Retinal fundus photograph.
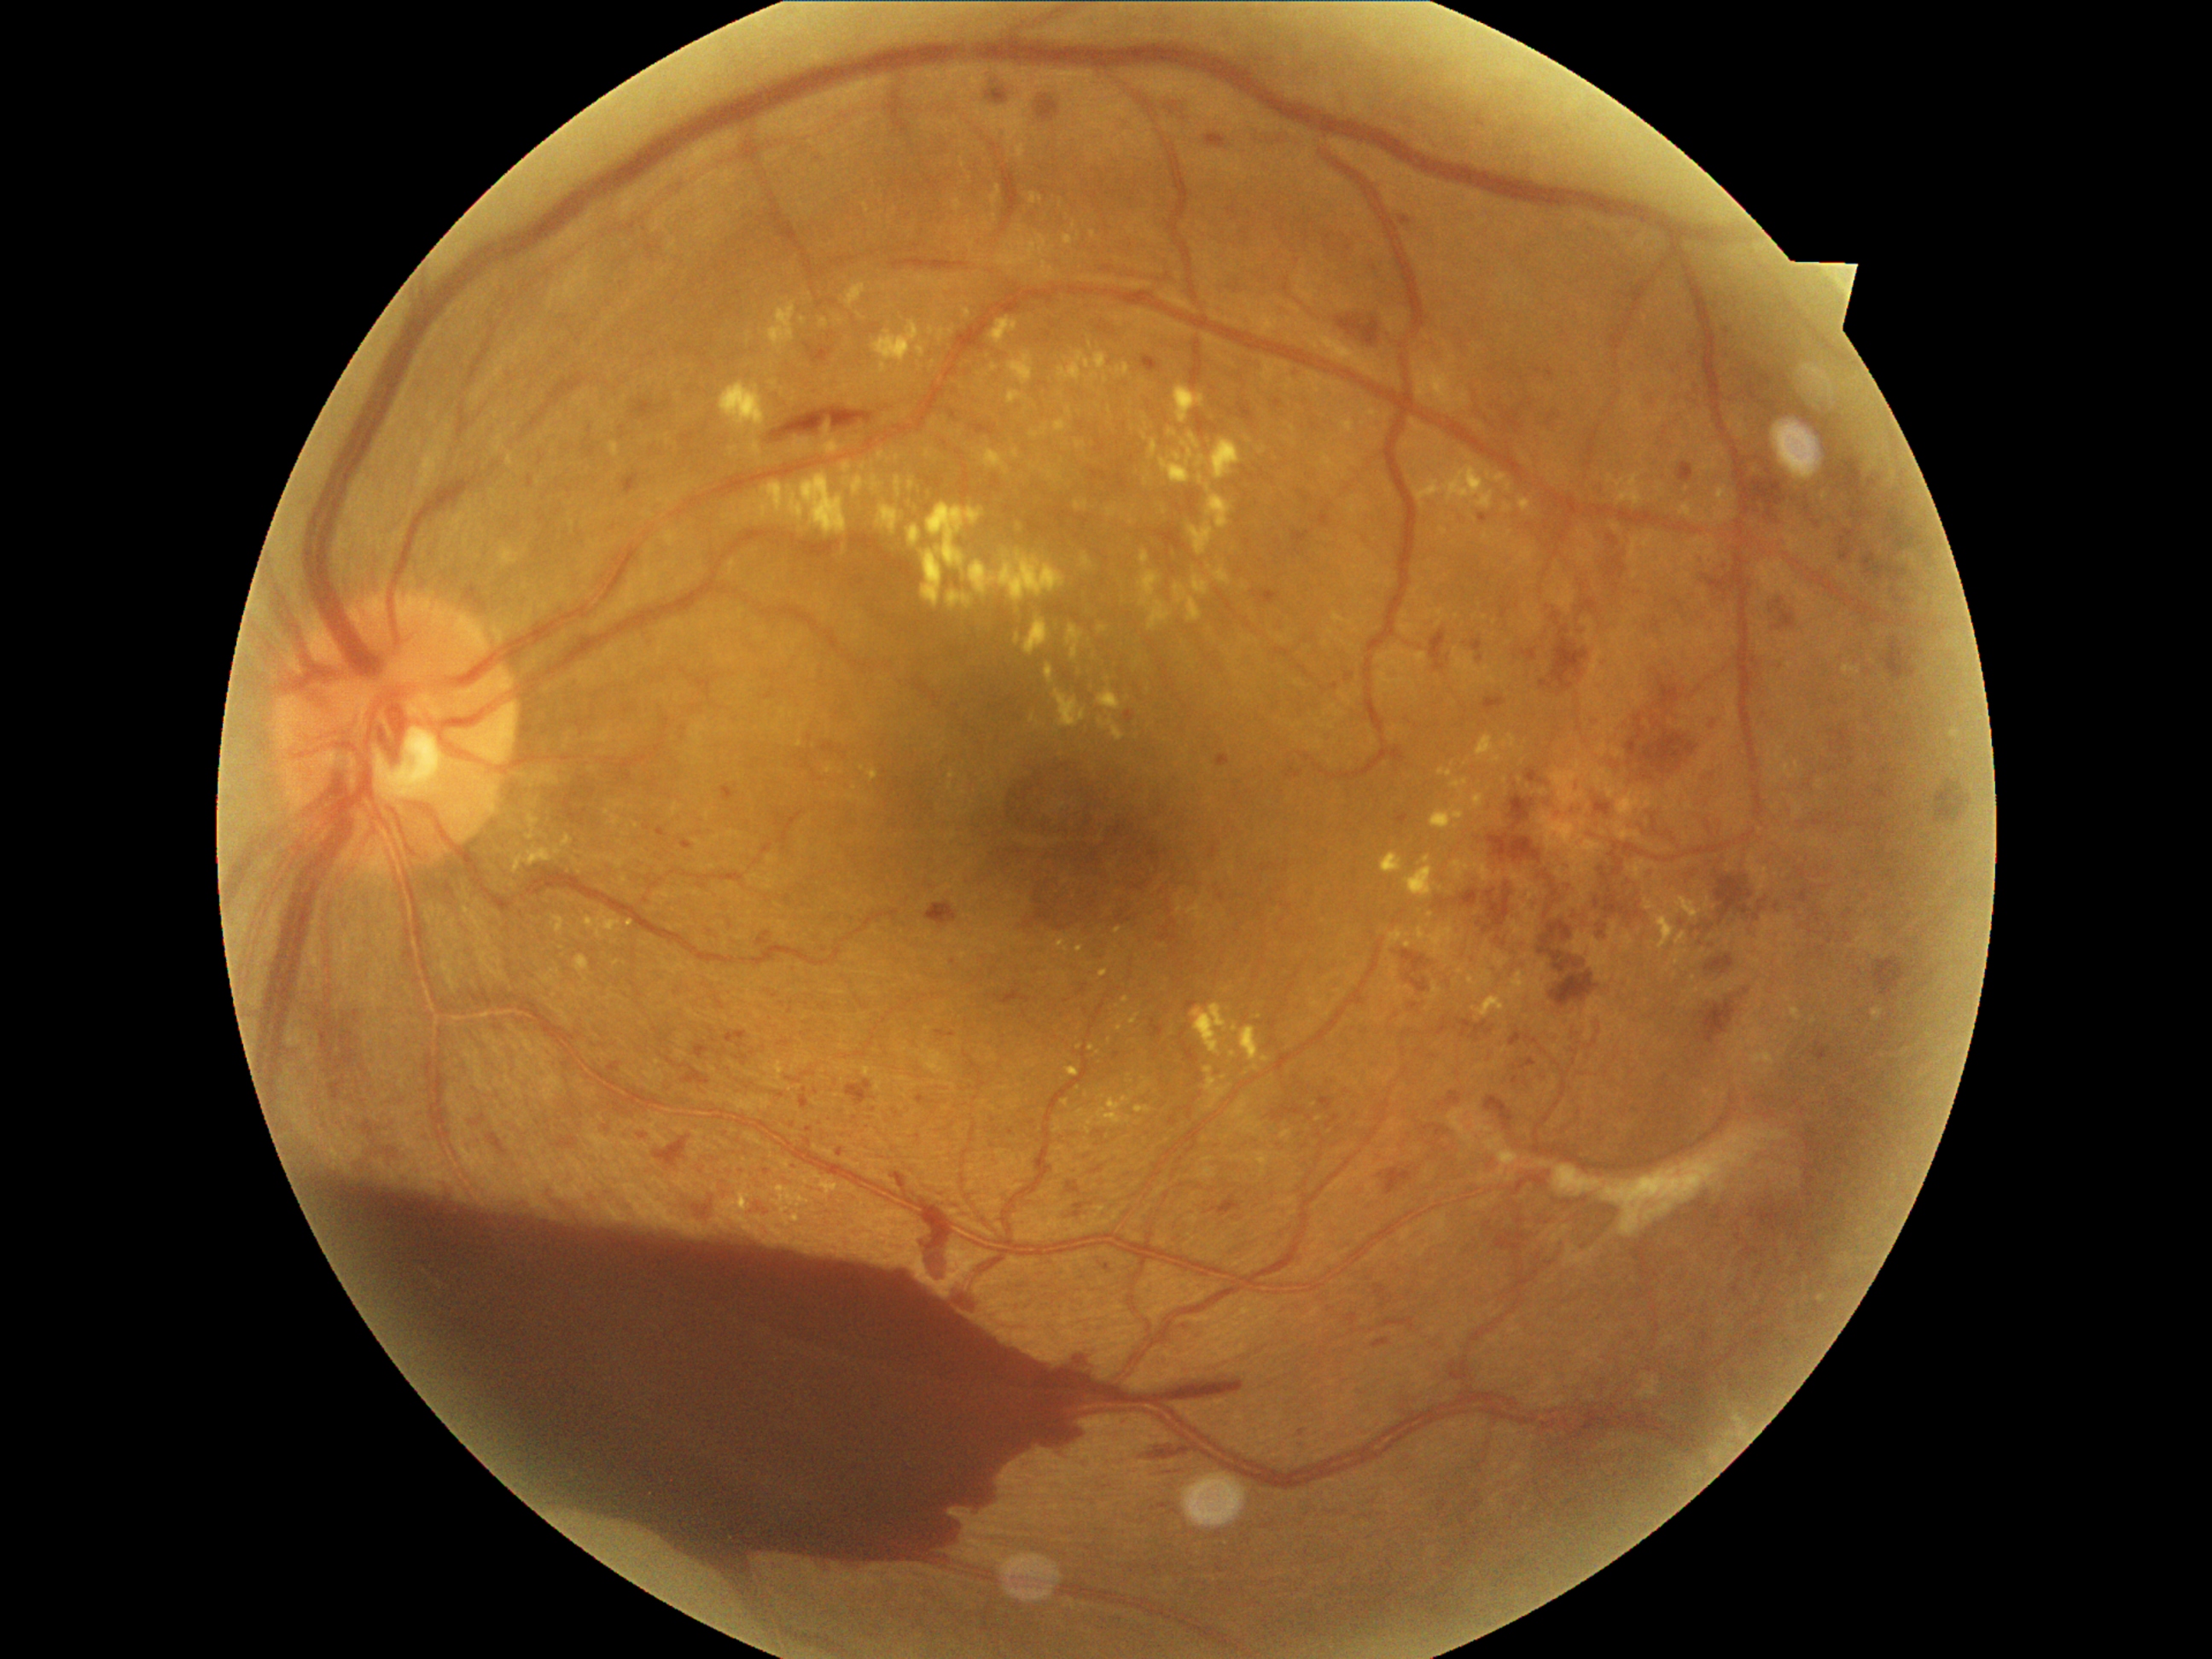

Diabetic retinopathy (DR): grade 4
Representative lesions:
hard exudates (EXs) (subset): bbox=(1015, 634, 1020, 644), bbox=(1503, 504, 1513, 513), bbox=(1653, 912, 1675, 952), bbox=(842, 462, 851, 474), bbox=(532, 853, 547, 868), bbox=(825, 424, 830, 438), bbox=(1081, 554, 1093, 569), bbox=(1677, 897, 1703, 919), bbox=(506, 453, 515, 467), bbox=(1173, 385, 1206, 424), bbox=(509, 859, 520, 873), bbox=(996, 233, 1056, 267), bbox=(1194, 576, 1211, 597)
Small EXs near [x=1233, y=1055], [x=1089, y=345], [x=794, y=400], [x=863, y=466], [x=1687, y=490], [x=1102, y=1097]